CFP; NIDEK AFC-230; DR severity per modified Davis staging:
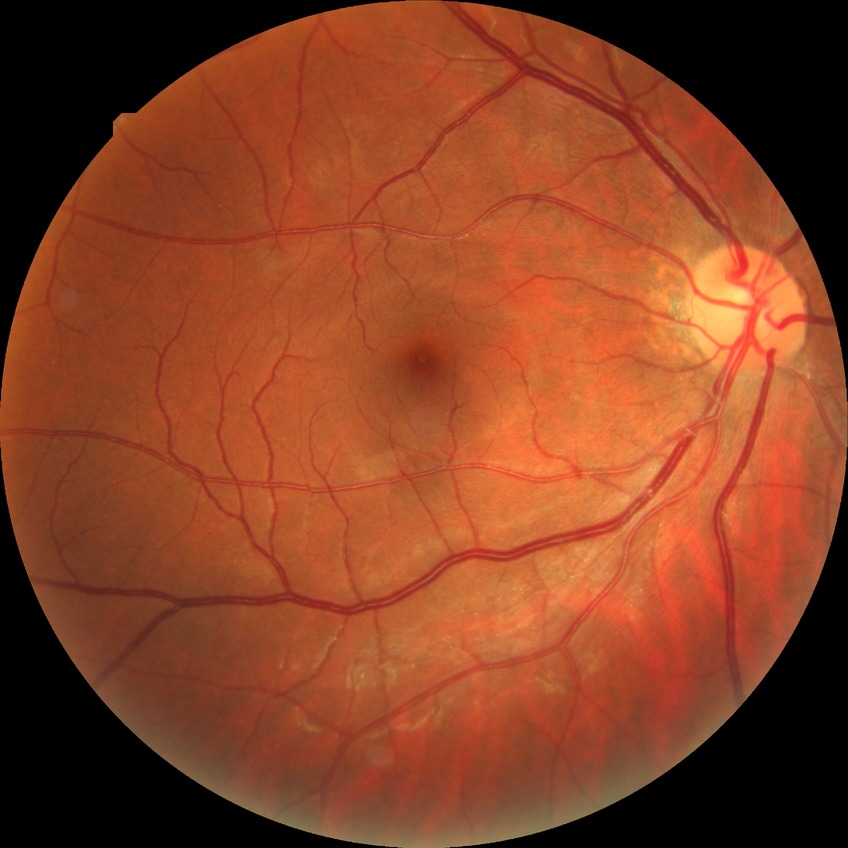

Diabetic retinopathy (DR): SDR (simple diabetic retinopathy).